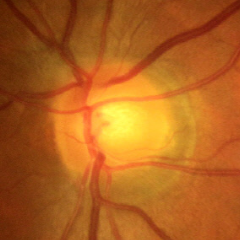
Findings consistent with no evidence of glaucoma.